45° FOV
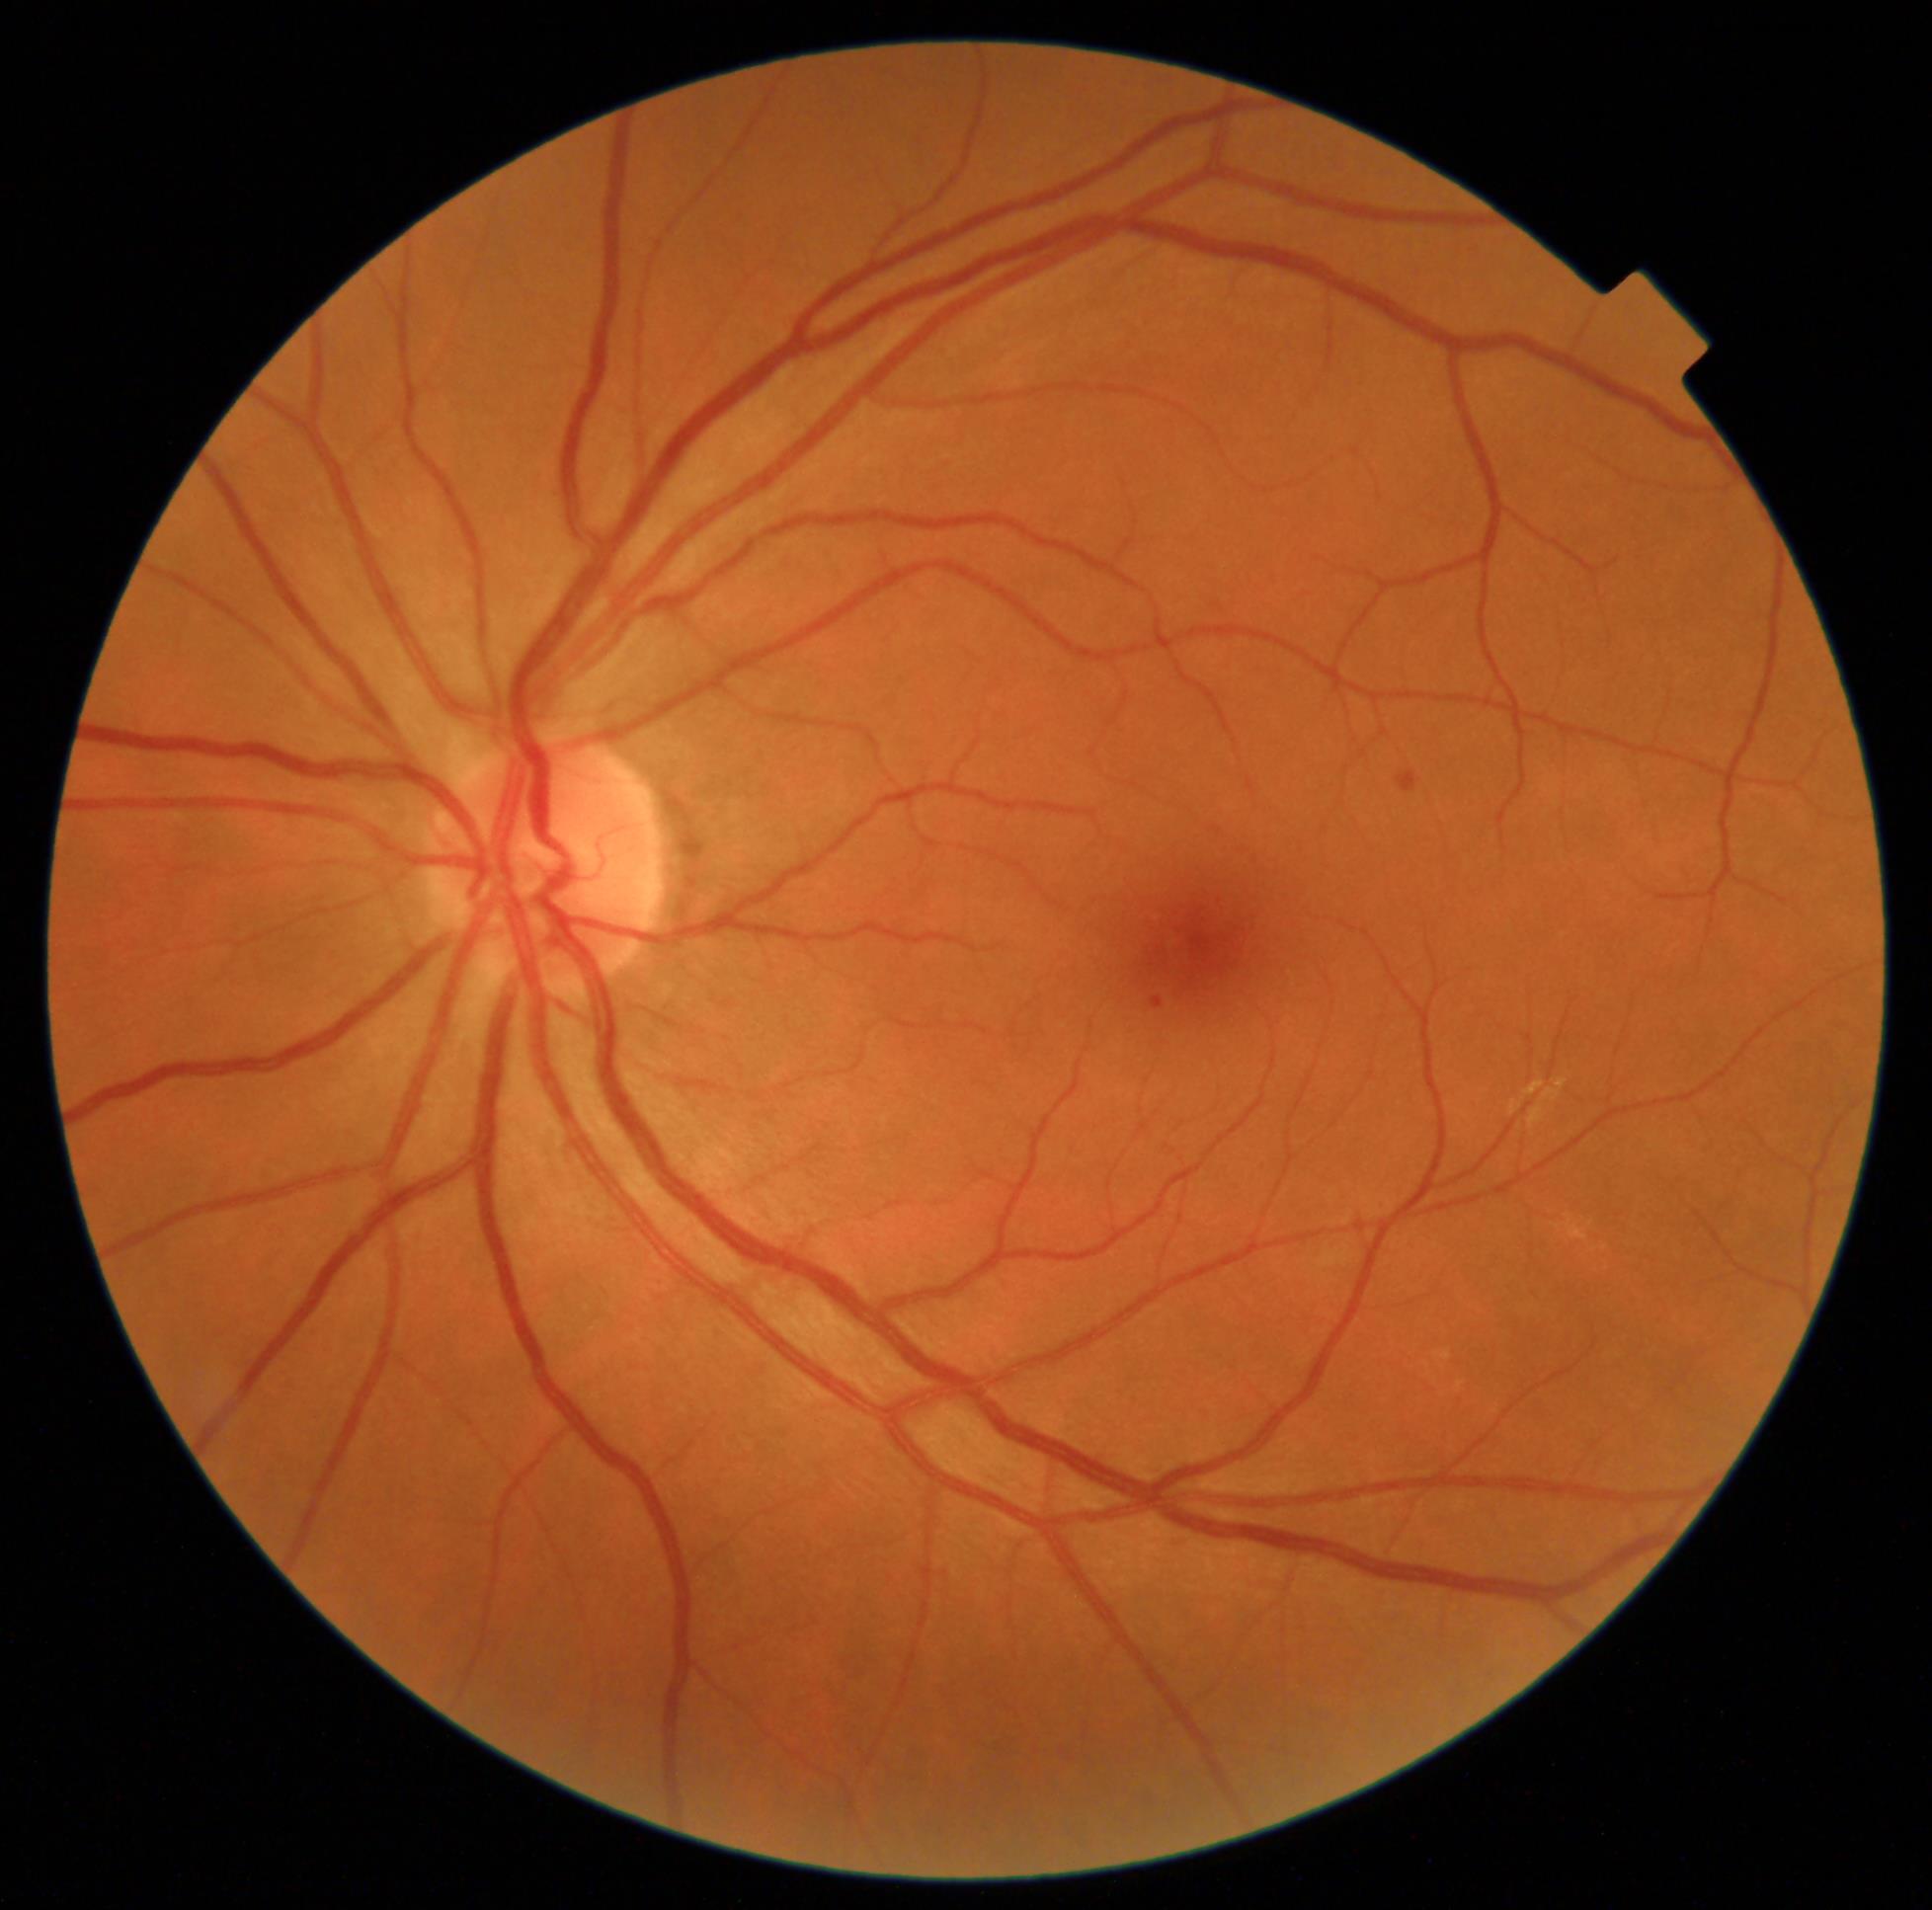
Findings:
– diabetic retinopathy grade — moderate non-proliferative diabetic retinopathy (2)